RetCam wide-field infant fundus image: 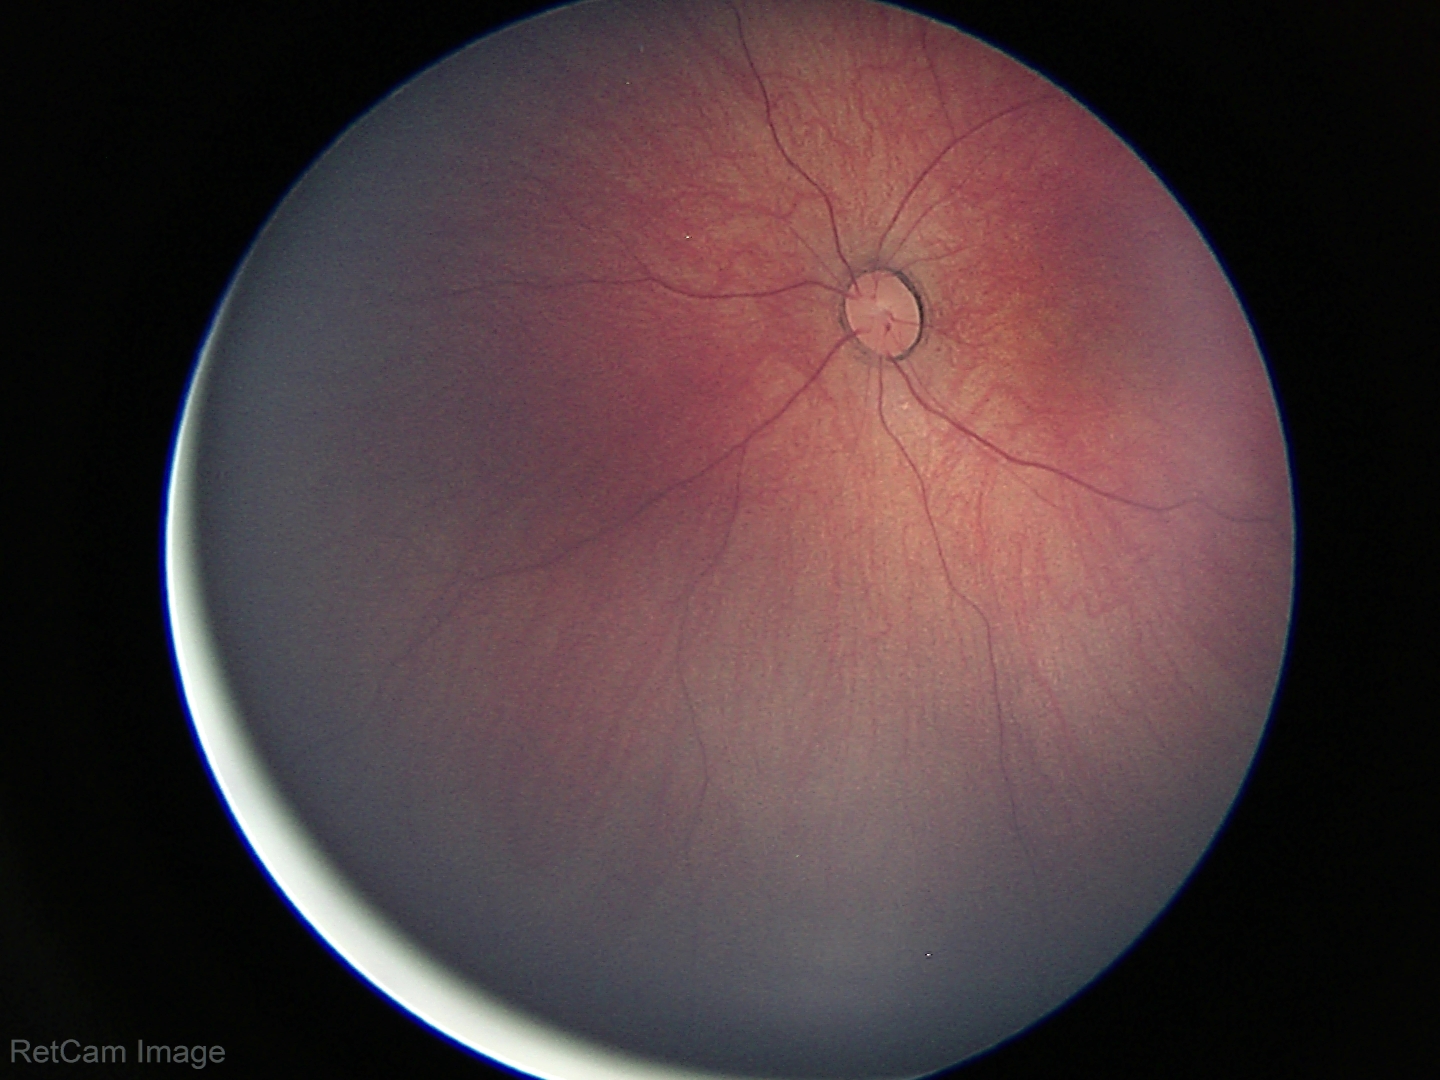
Screening examination with no abnormal retinal findings.